Fundus photo; image size 1932x1932; FOV: 45 degrees.
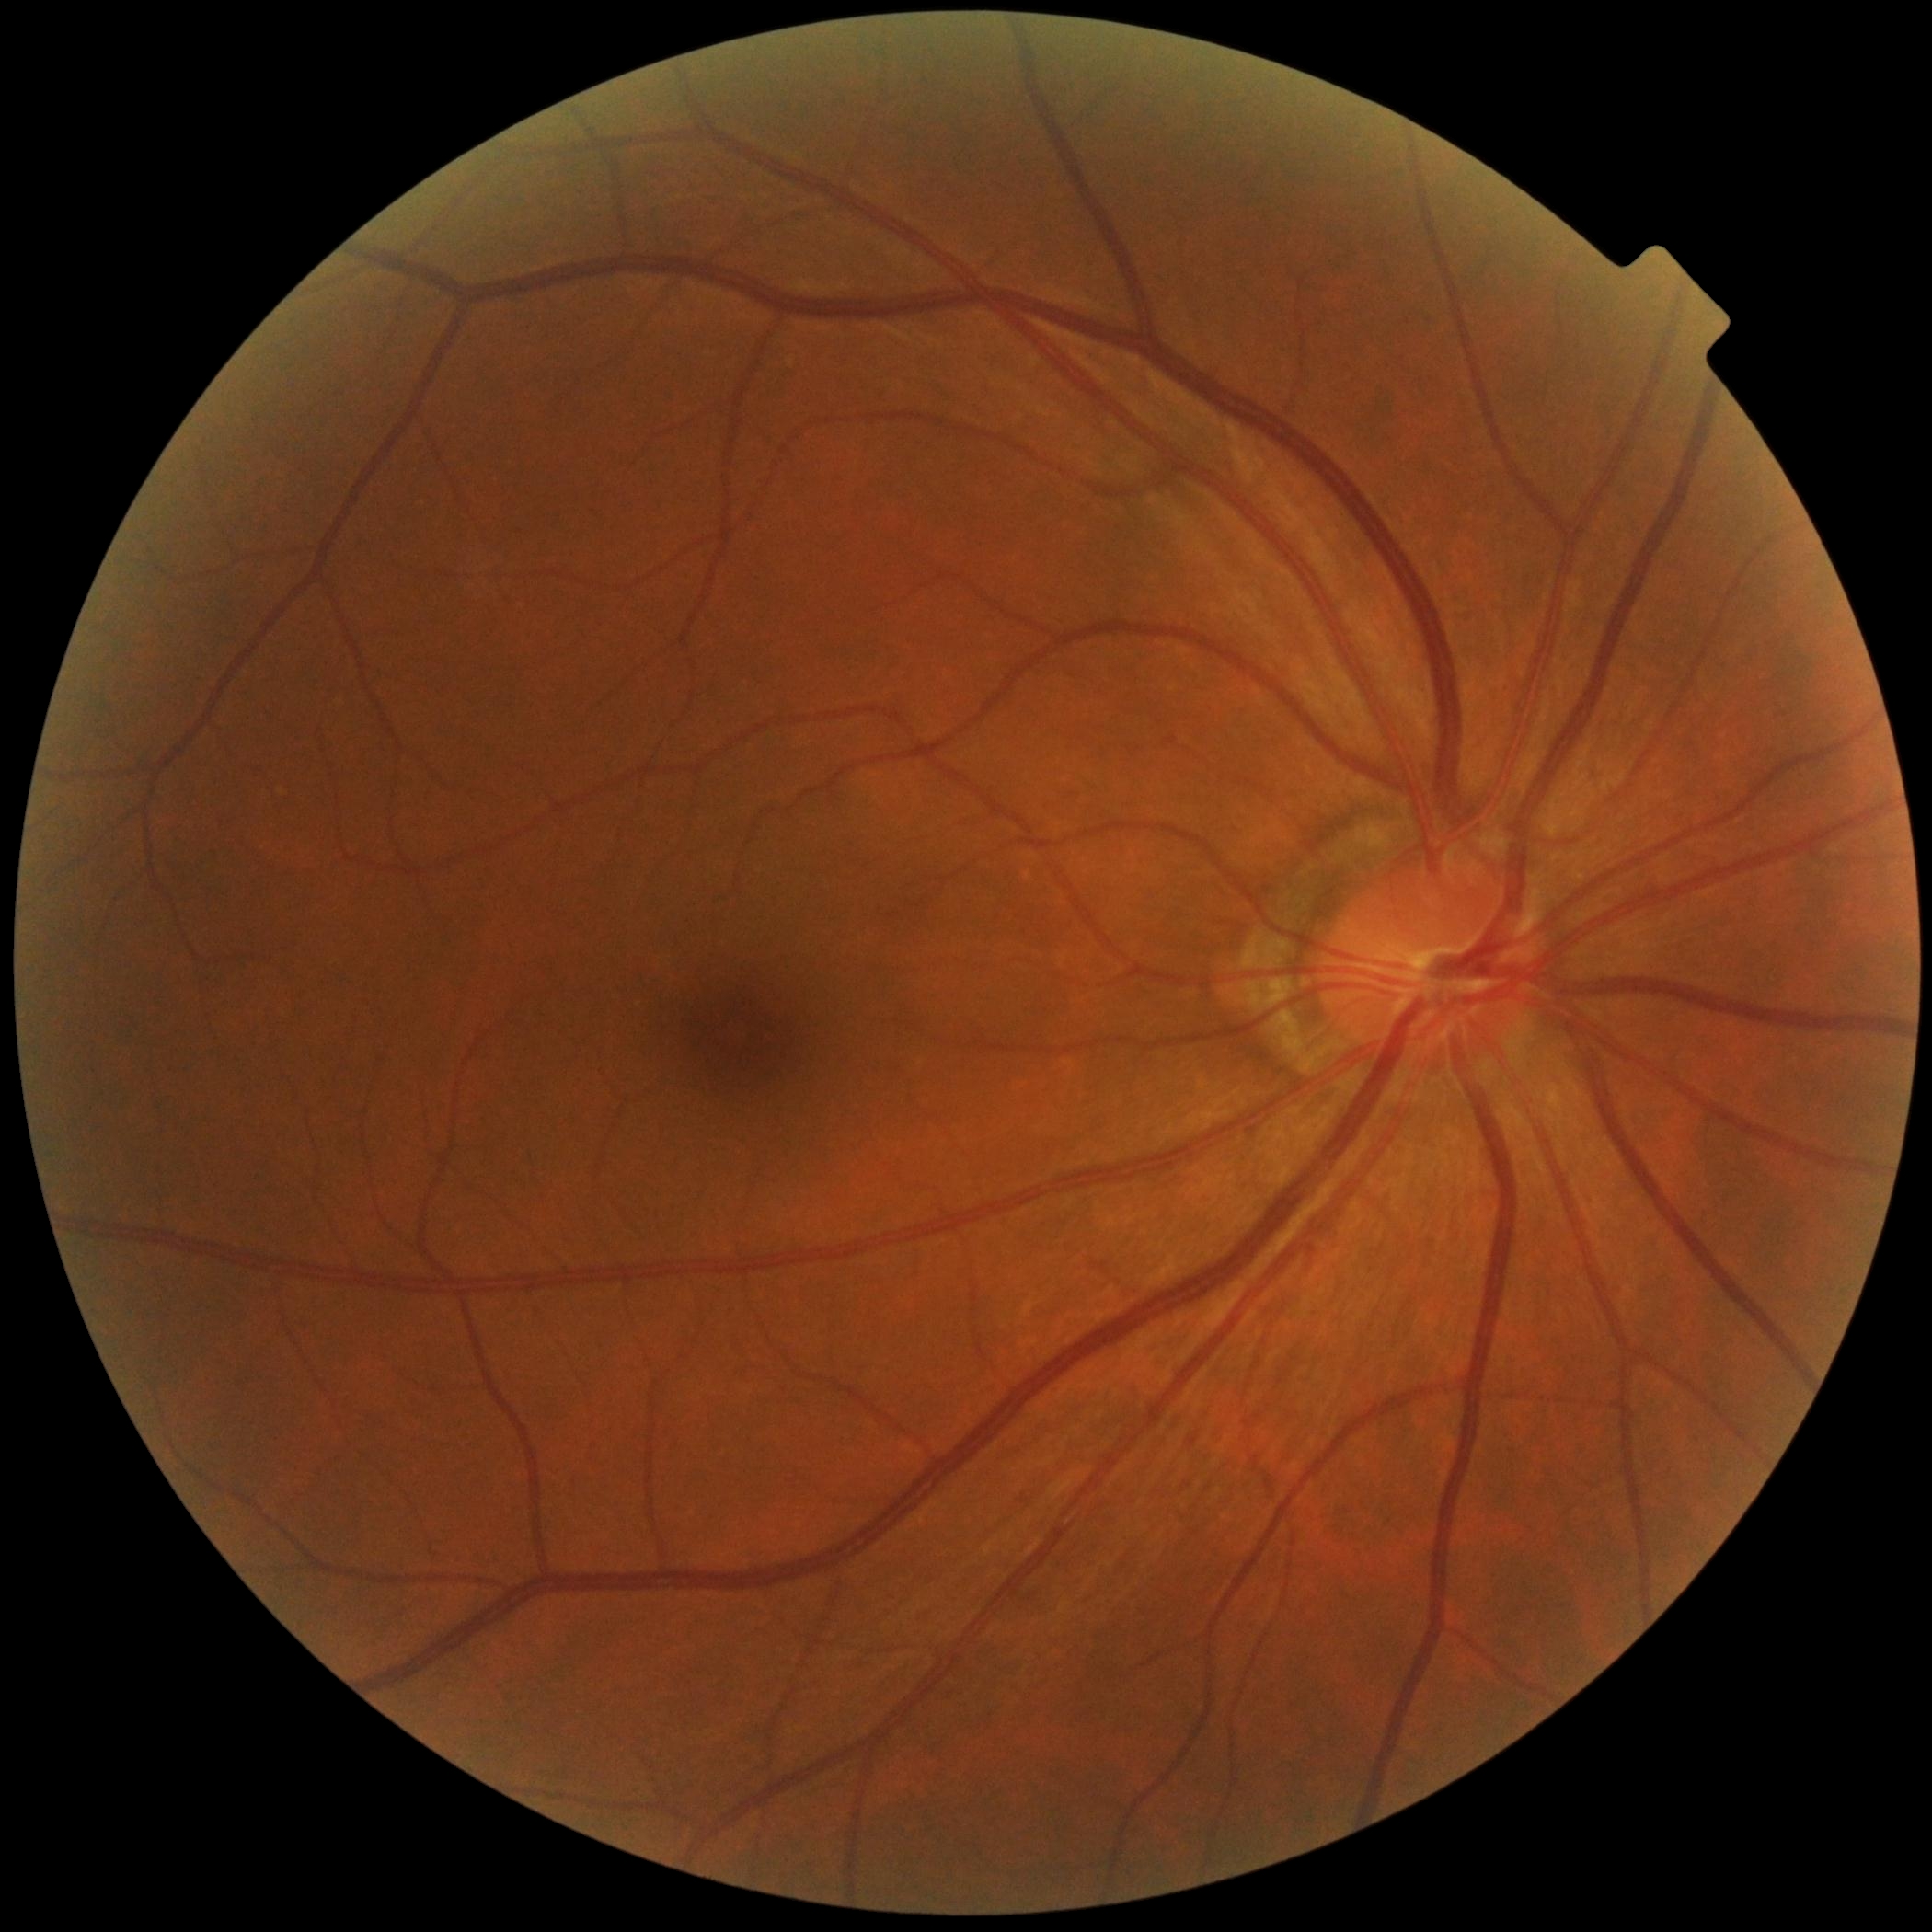
DR: grade 0 (no apparent retinopathy).